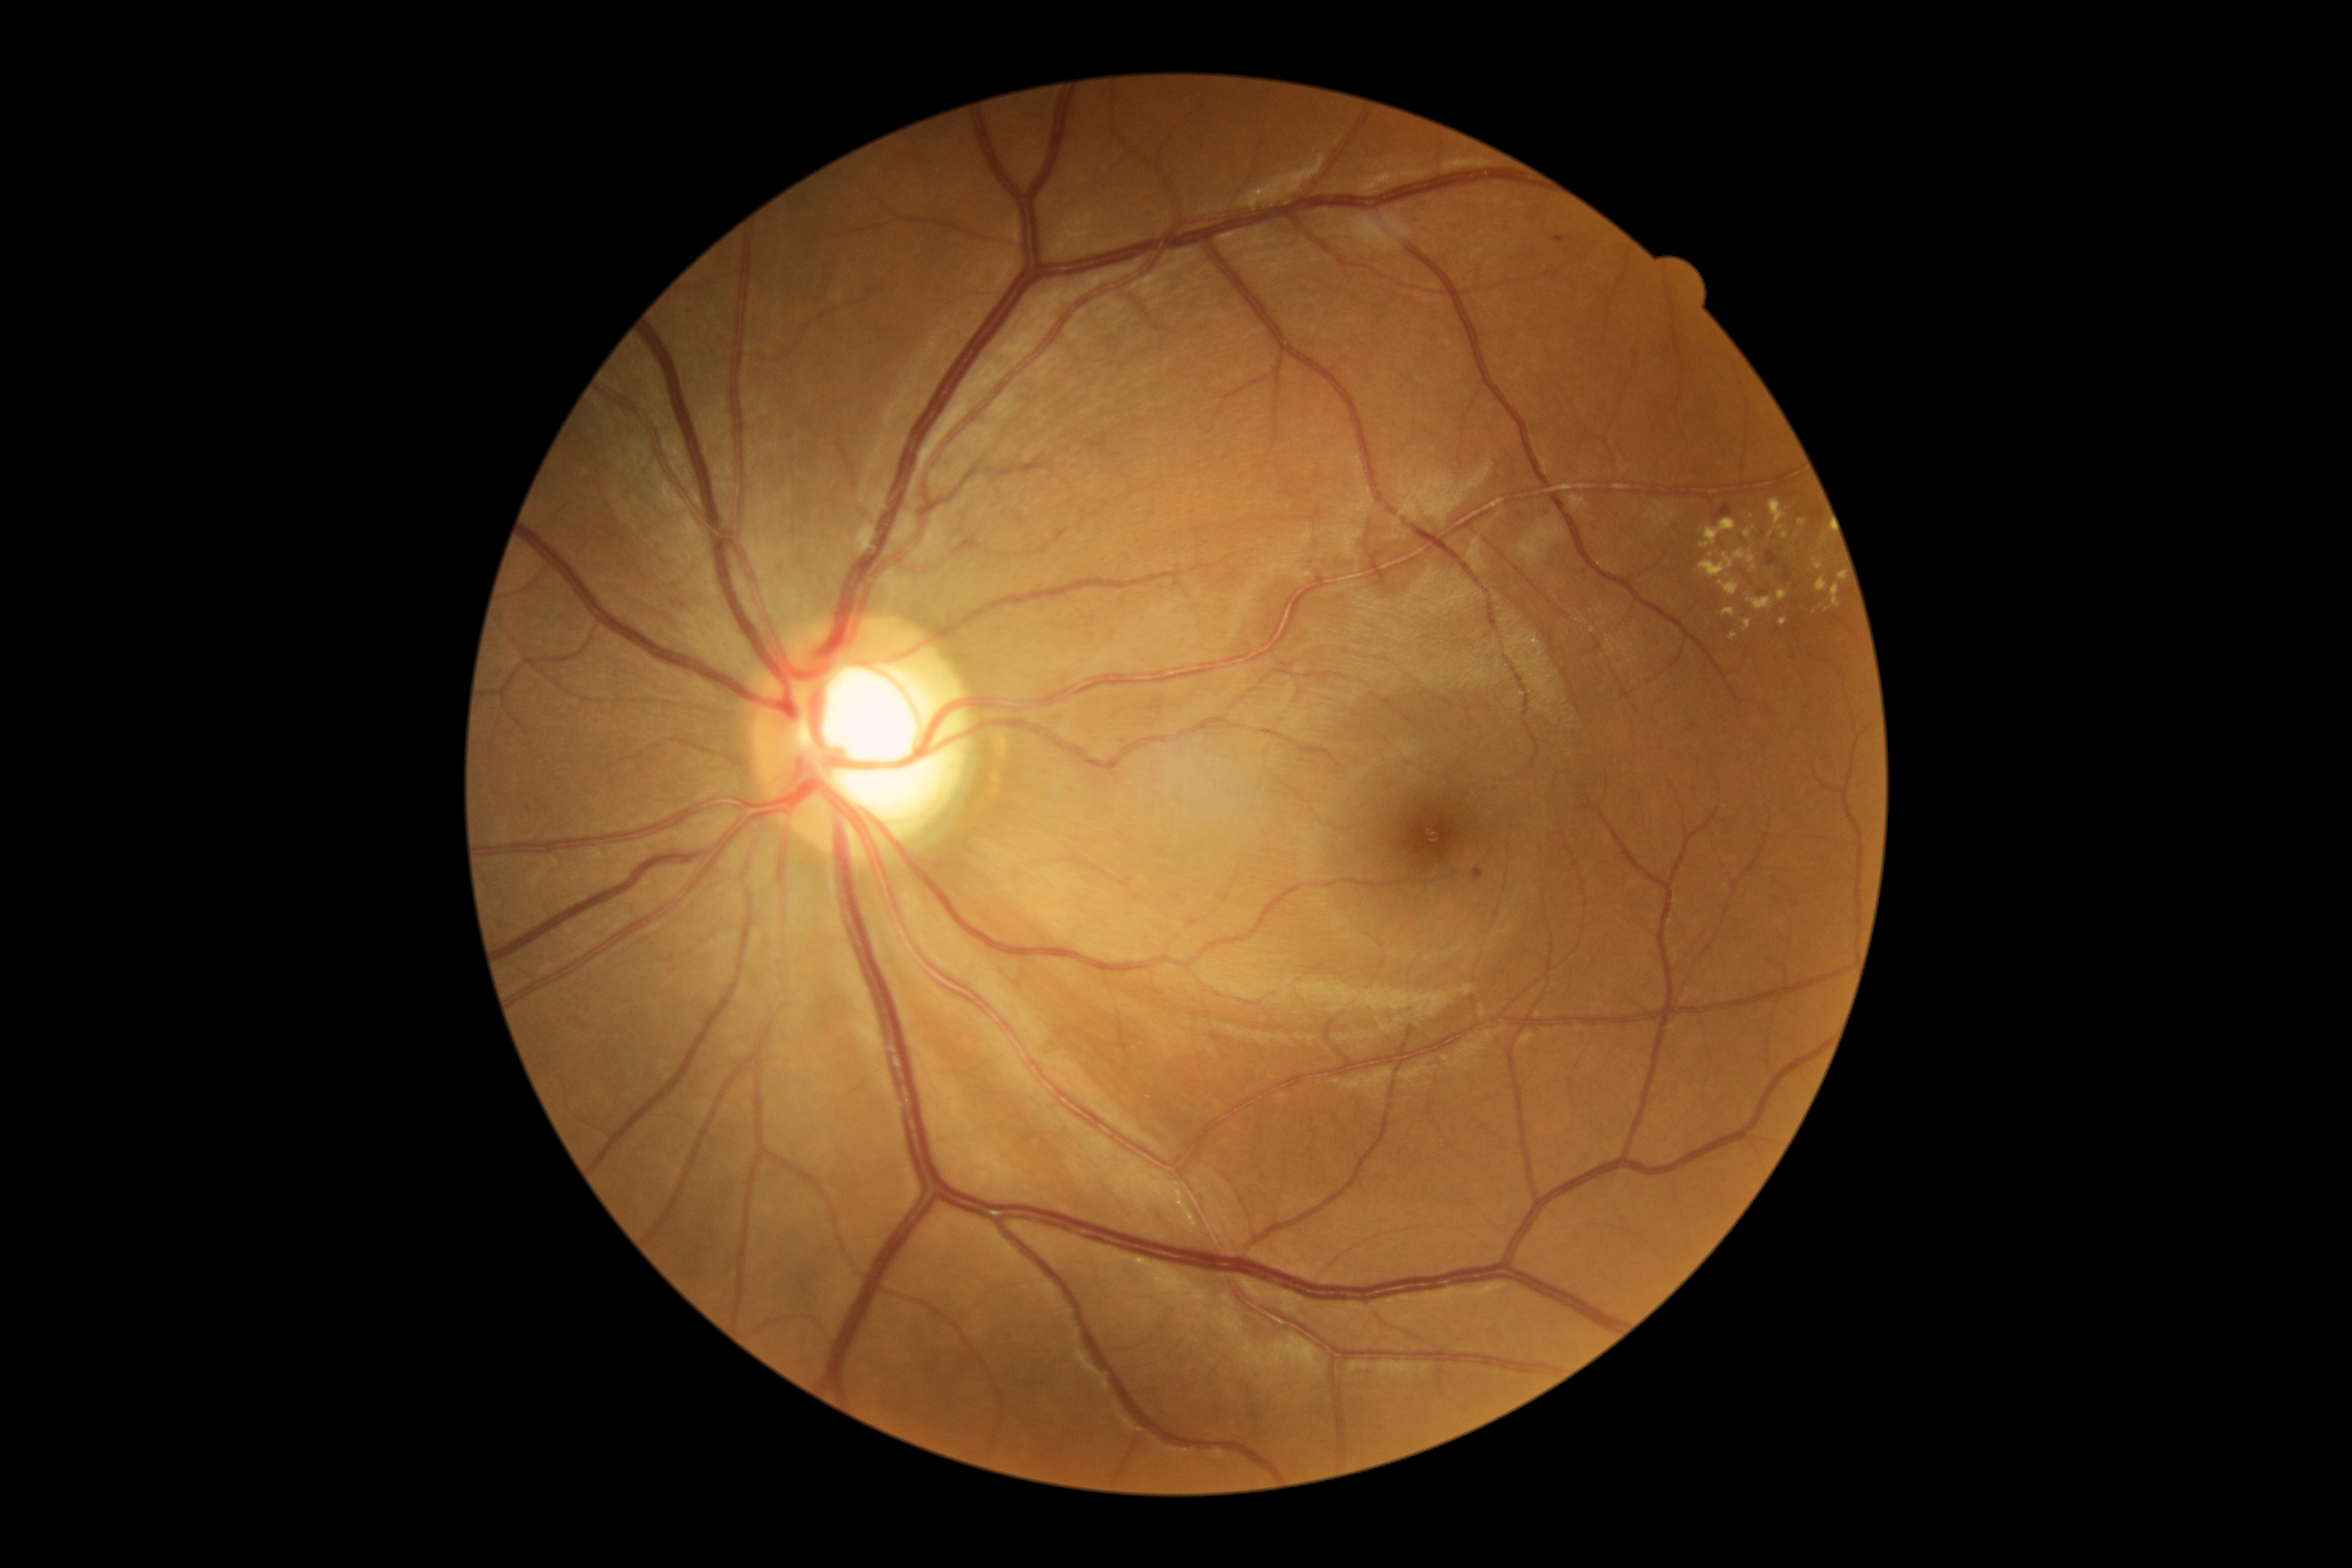
Retinopathy grade: 2 (moderate NPDR).
Hard exudates (partial list) at [1729, 634, 1737, 640] | [1744, 530, 1753, 539] | [1700, 549, 1758, 577] | [1837, 573, 1844, 582] | [1701, 518, 1736, 548] | [1815, 579, 1828, 592] | [1748, 594, 1773, 611] | [1770, 499, 1789, 541] | [1779, 591, 1789, 601] | [1779, 620, 1787, 627] | [1743, 622, 1753, 632] | [1718, 580, 1741, 596] | [1722, 608, 1736, 618] | [1830, 584, 1841, 608] | [1813, 560, 1822, 570].
Smaller hard exudates around 1826/610 | 1711/556 | 1771/534 | 1802/522.
No soft exudates identified.
Microaneurysms (partial list) at [1473, 869, 1485, 879] | [1712, 505, 1732, 520] | [1553, 236, 1565, 245] | [1758, 592, 1768, 597] | [1767, 551, 1780, 567] | [666, 957, 675, 964] | [1782, 568, 1791, 582].
Smaller microaneurysms around 1158/993.
No hemorrhages identified.